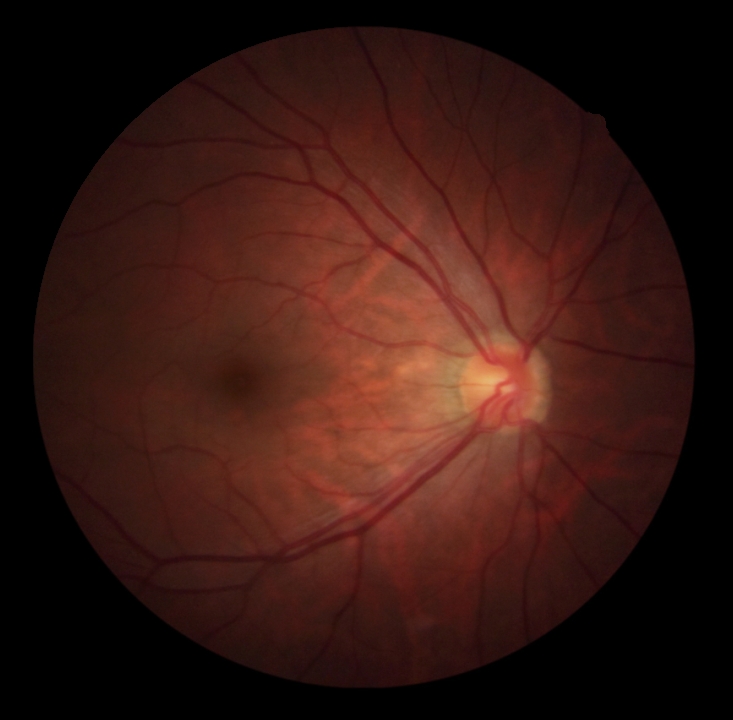
dr_grade: grade 0 (no apparent retinopathy)